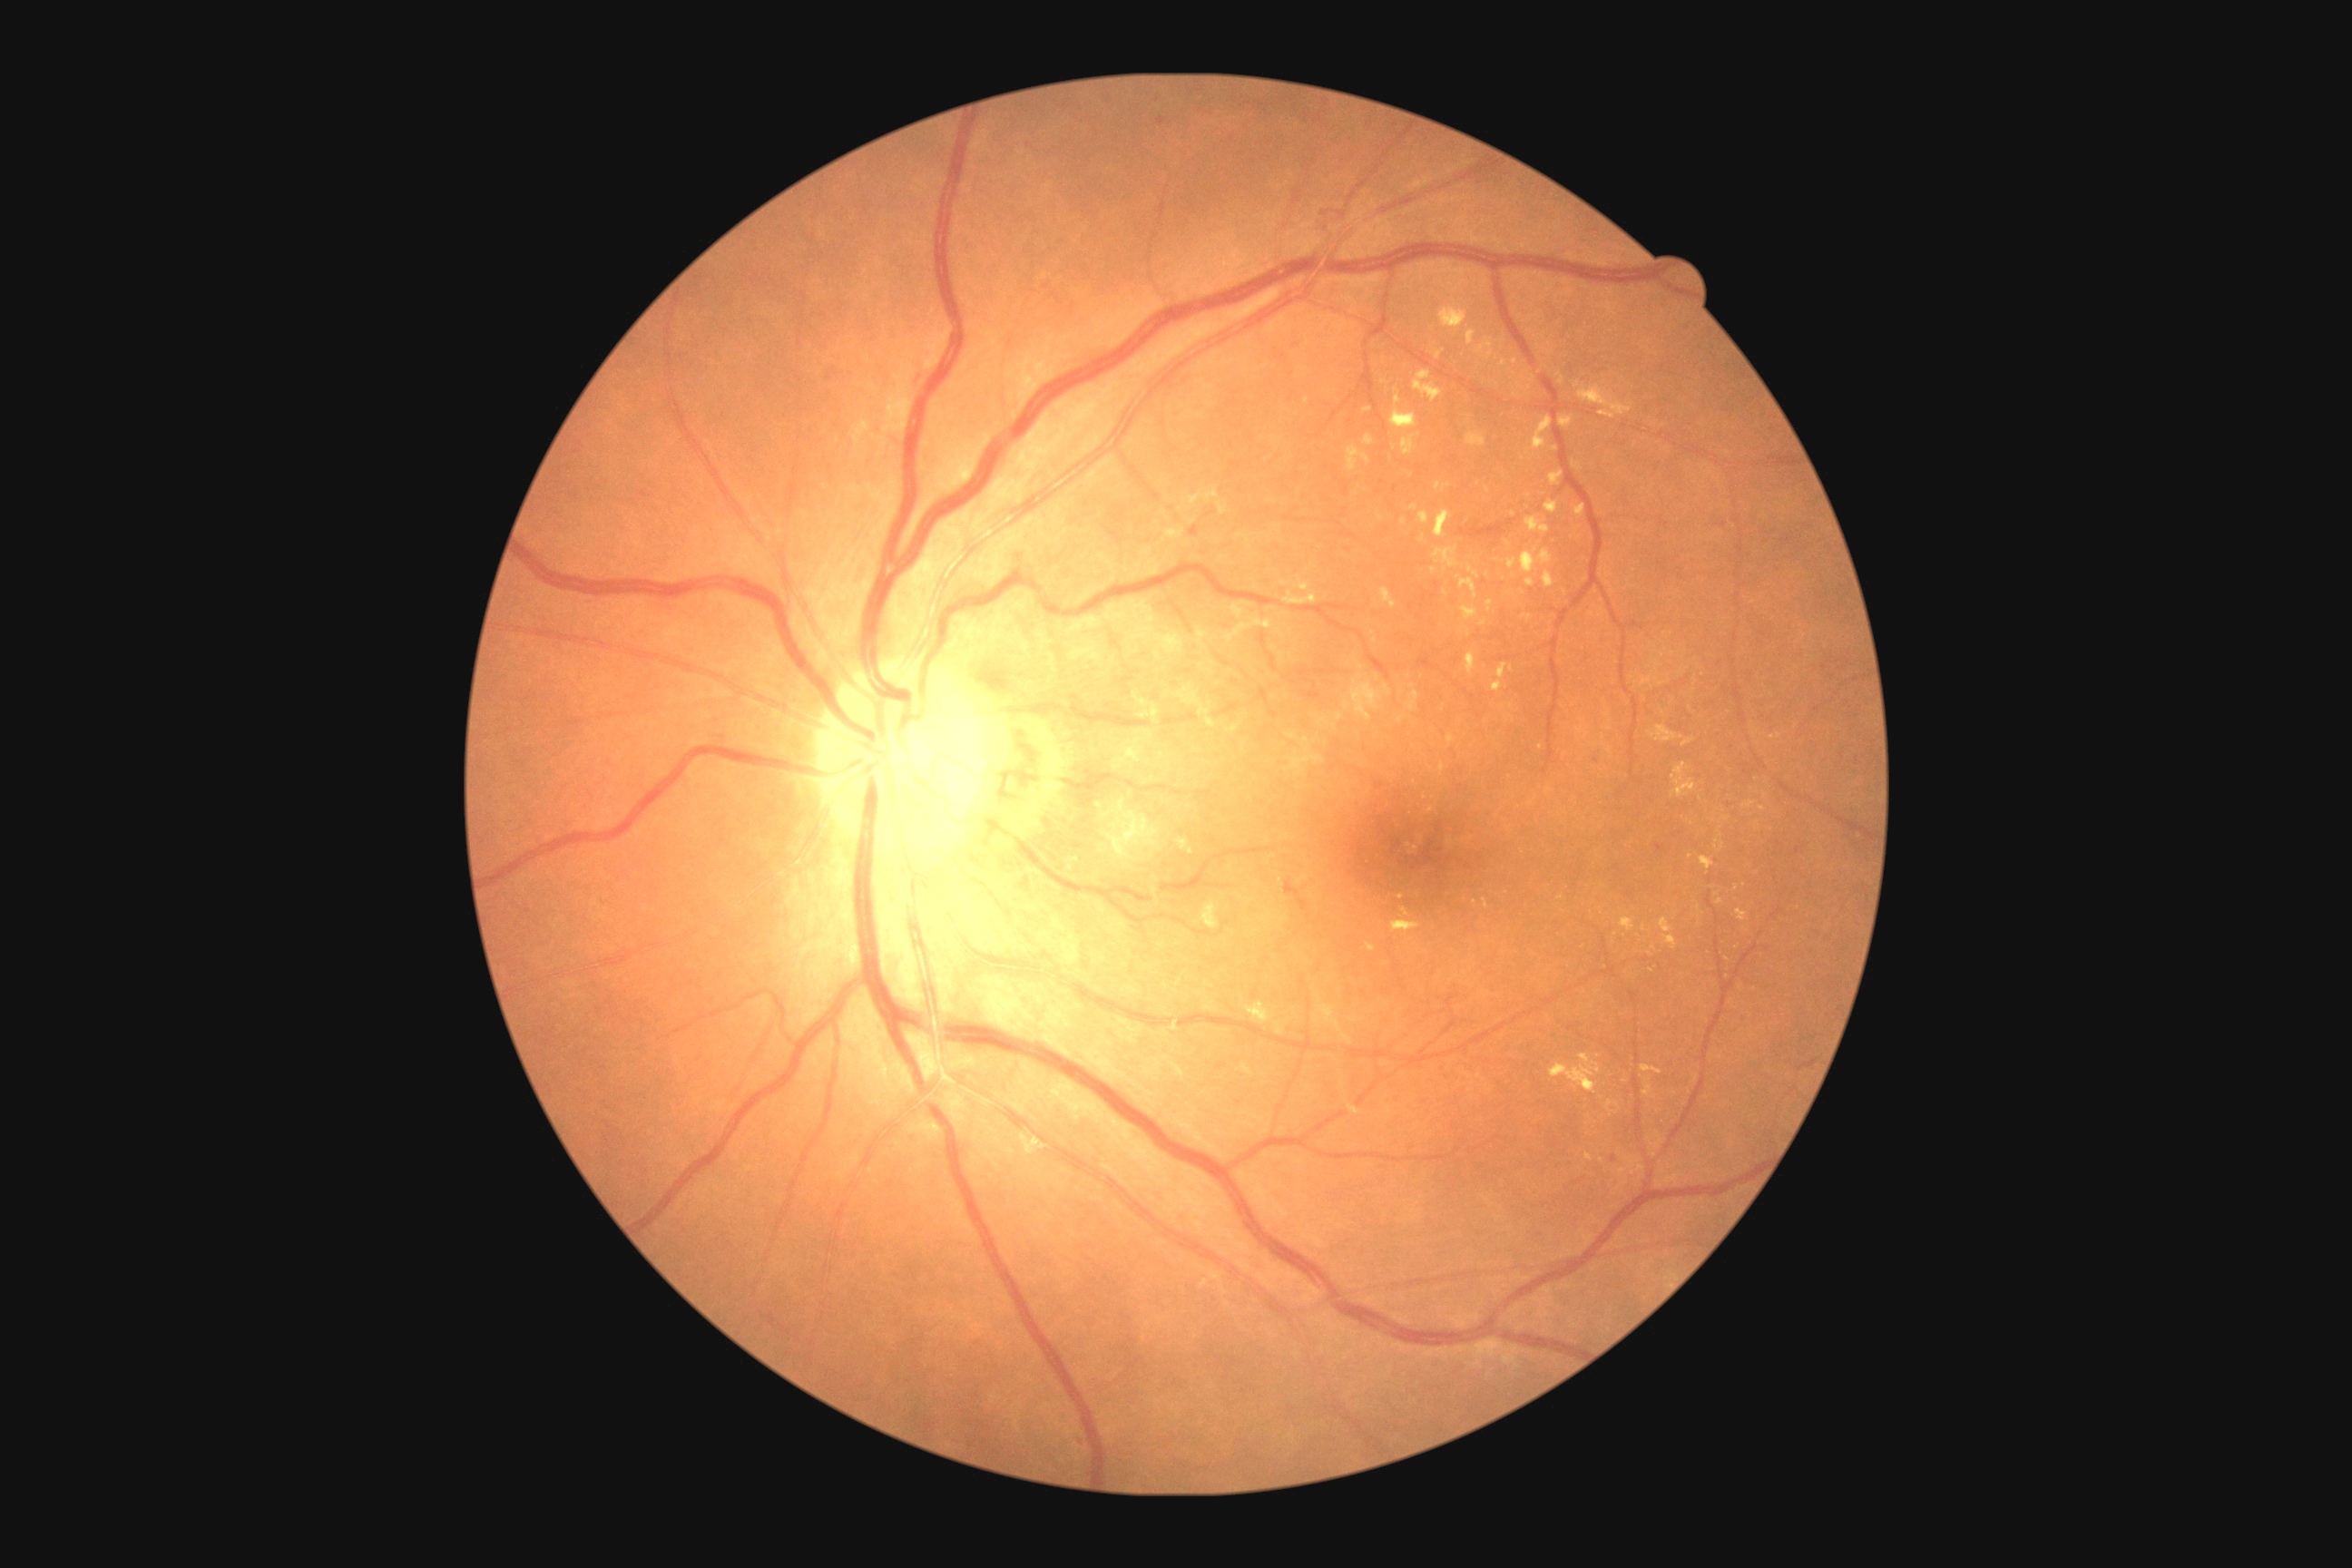

Diabetic retinopathy (DR): grade 2 (moderate NPDR).